45° FOV: 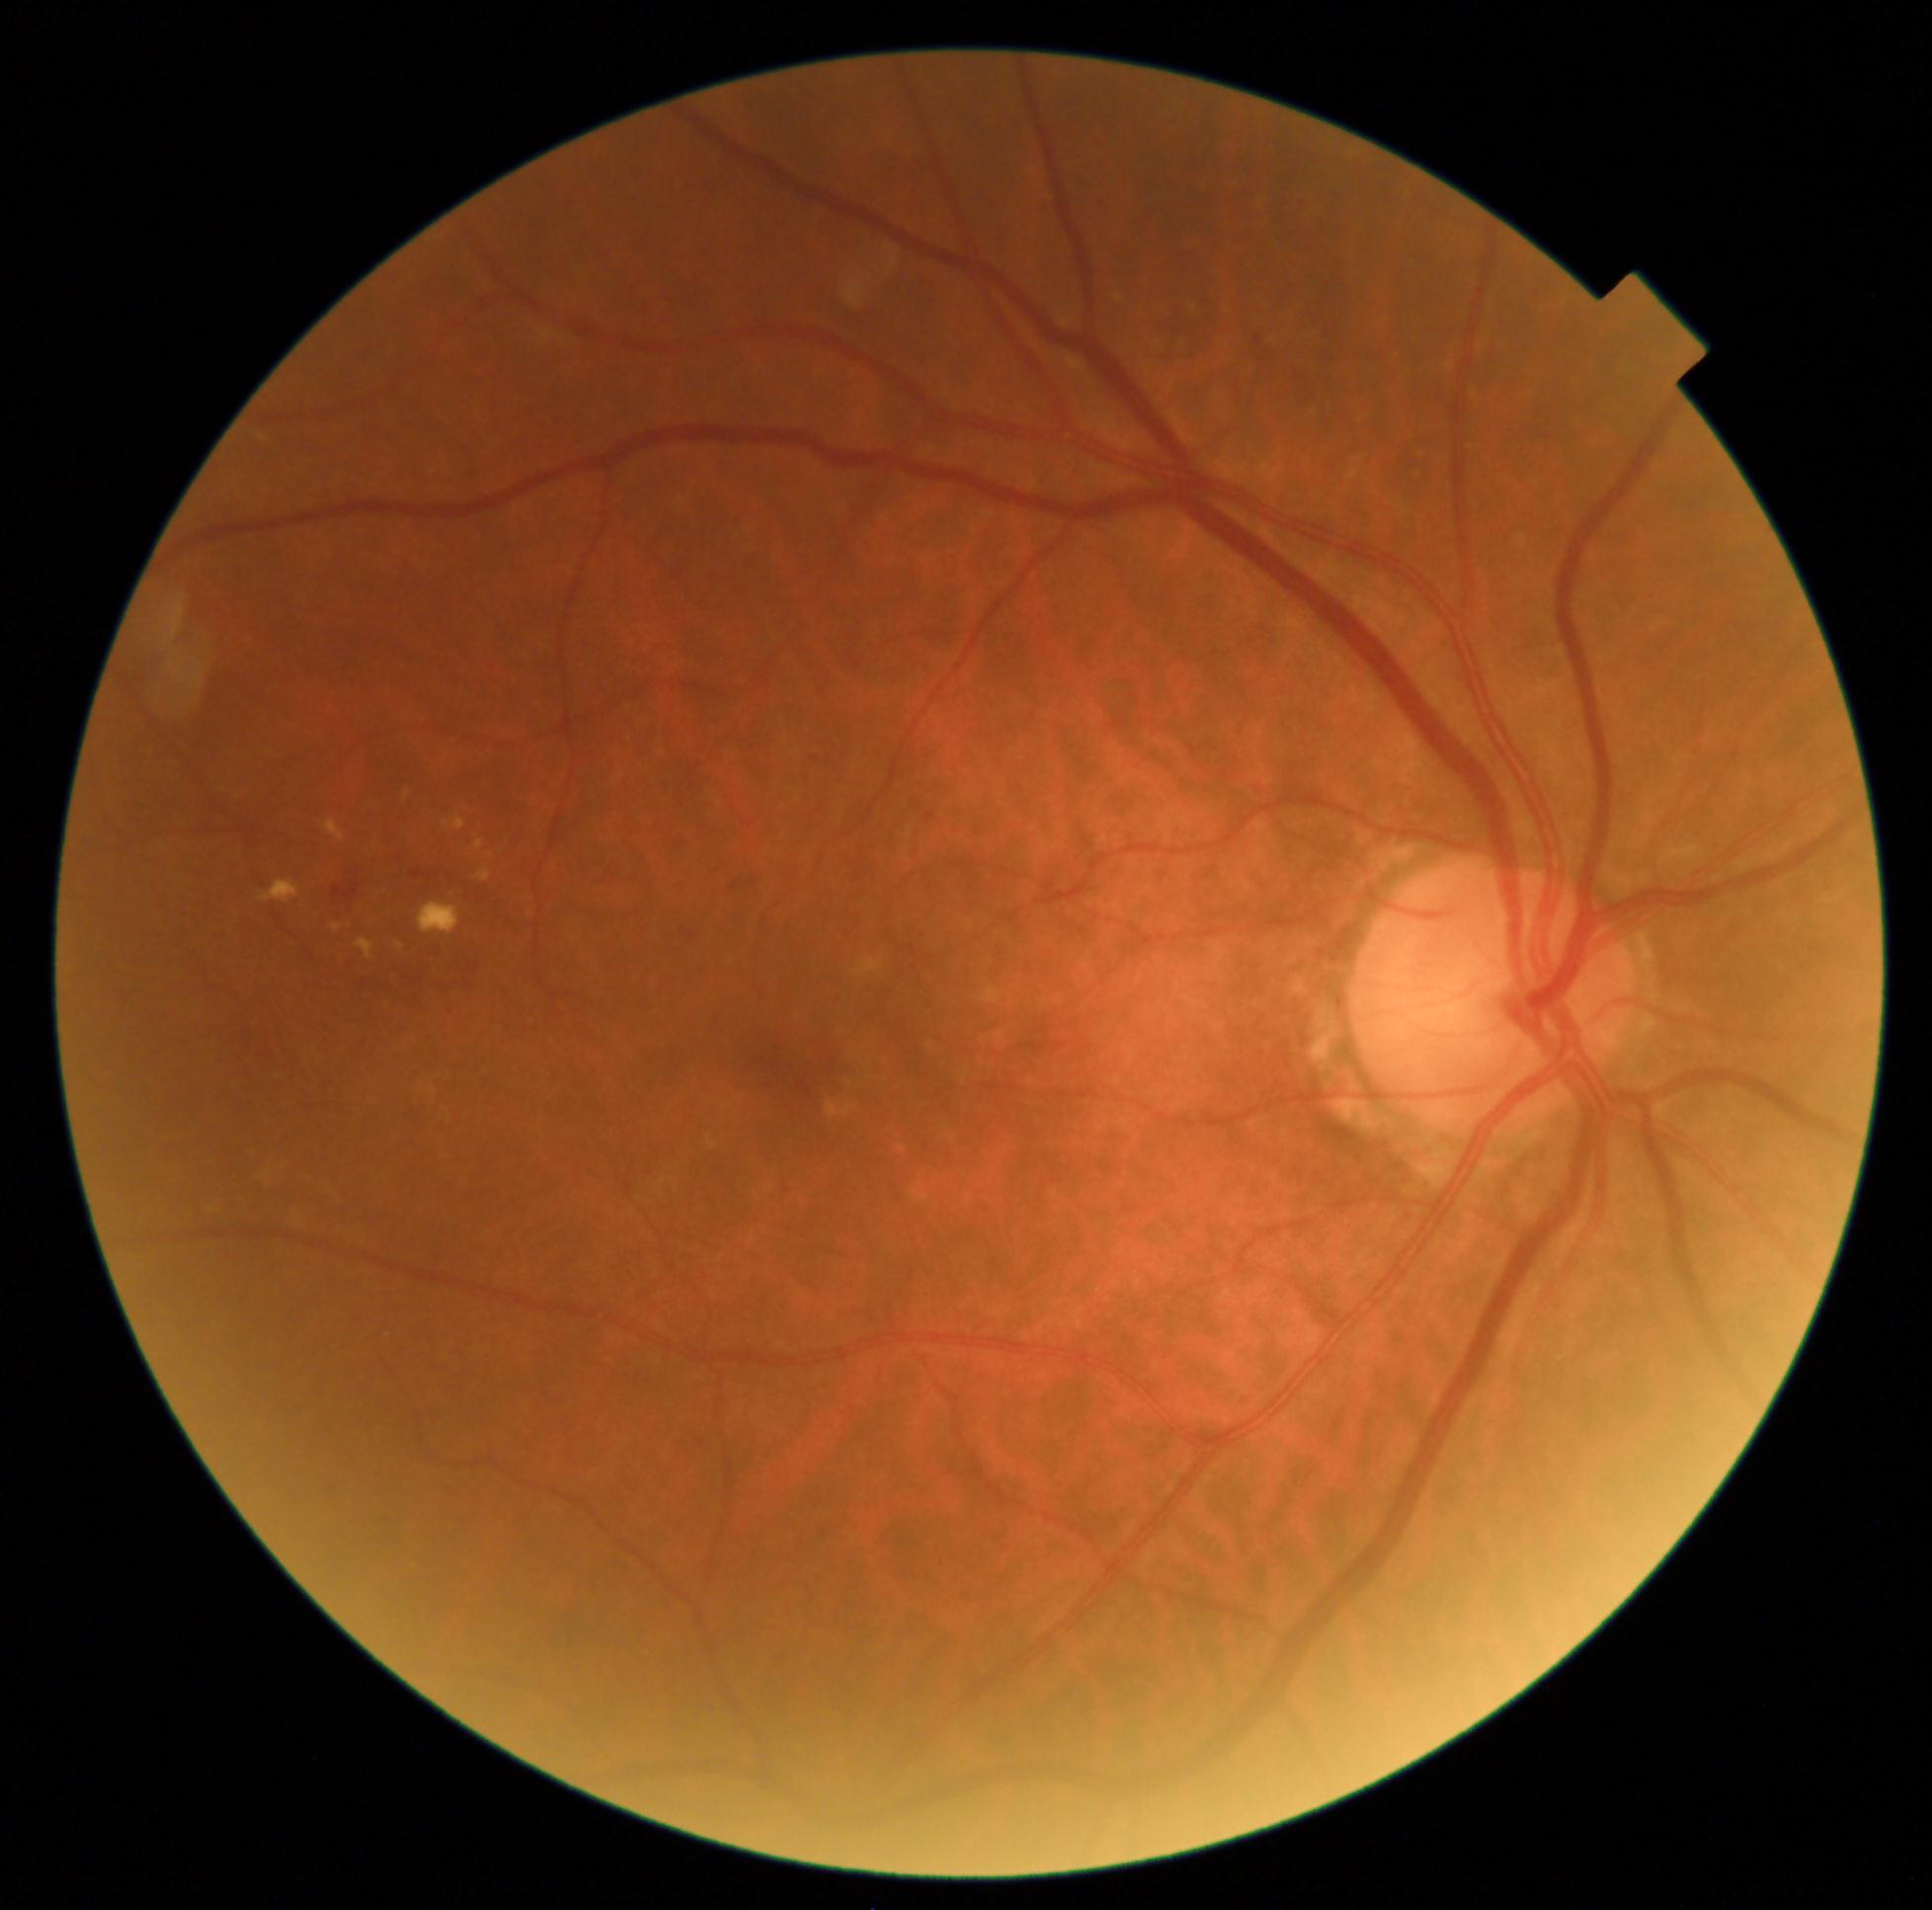

  dr_category: non-proliferative diabetic retinopathy
  dr_grade: grade 2 (moderate NPDR) — more than just microaneurysms but less than severe NPDR